Axial length 23.43 mm. Age 71. Optic disc at the center of the field. Corneal thickness 560 µm
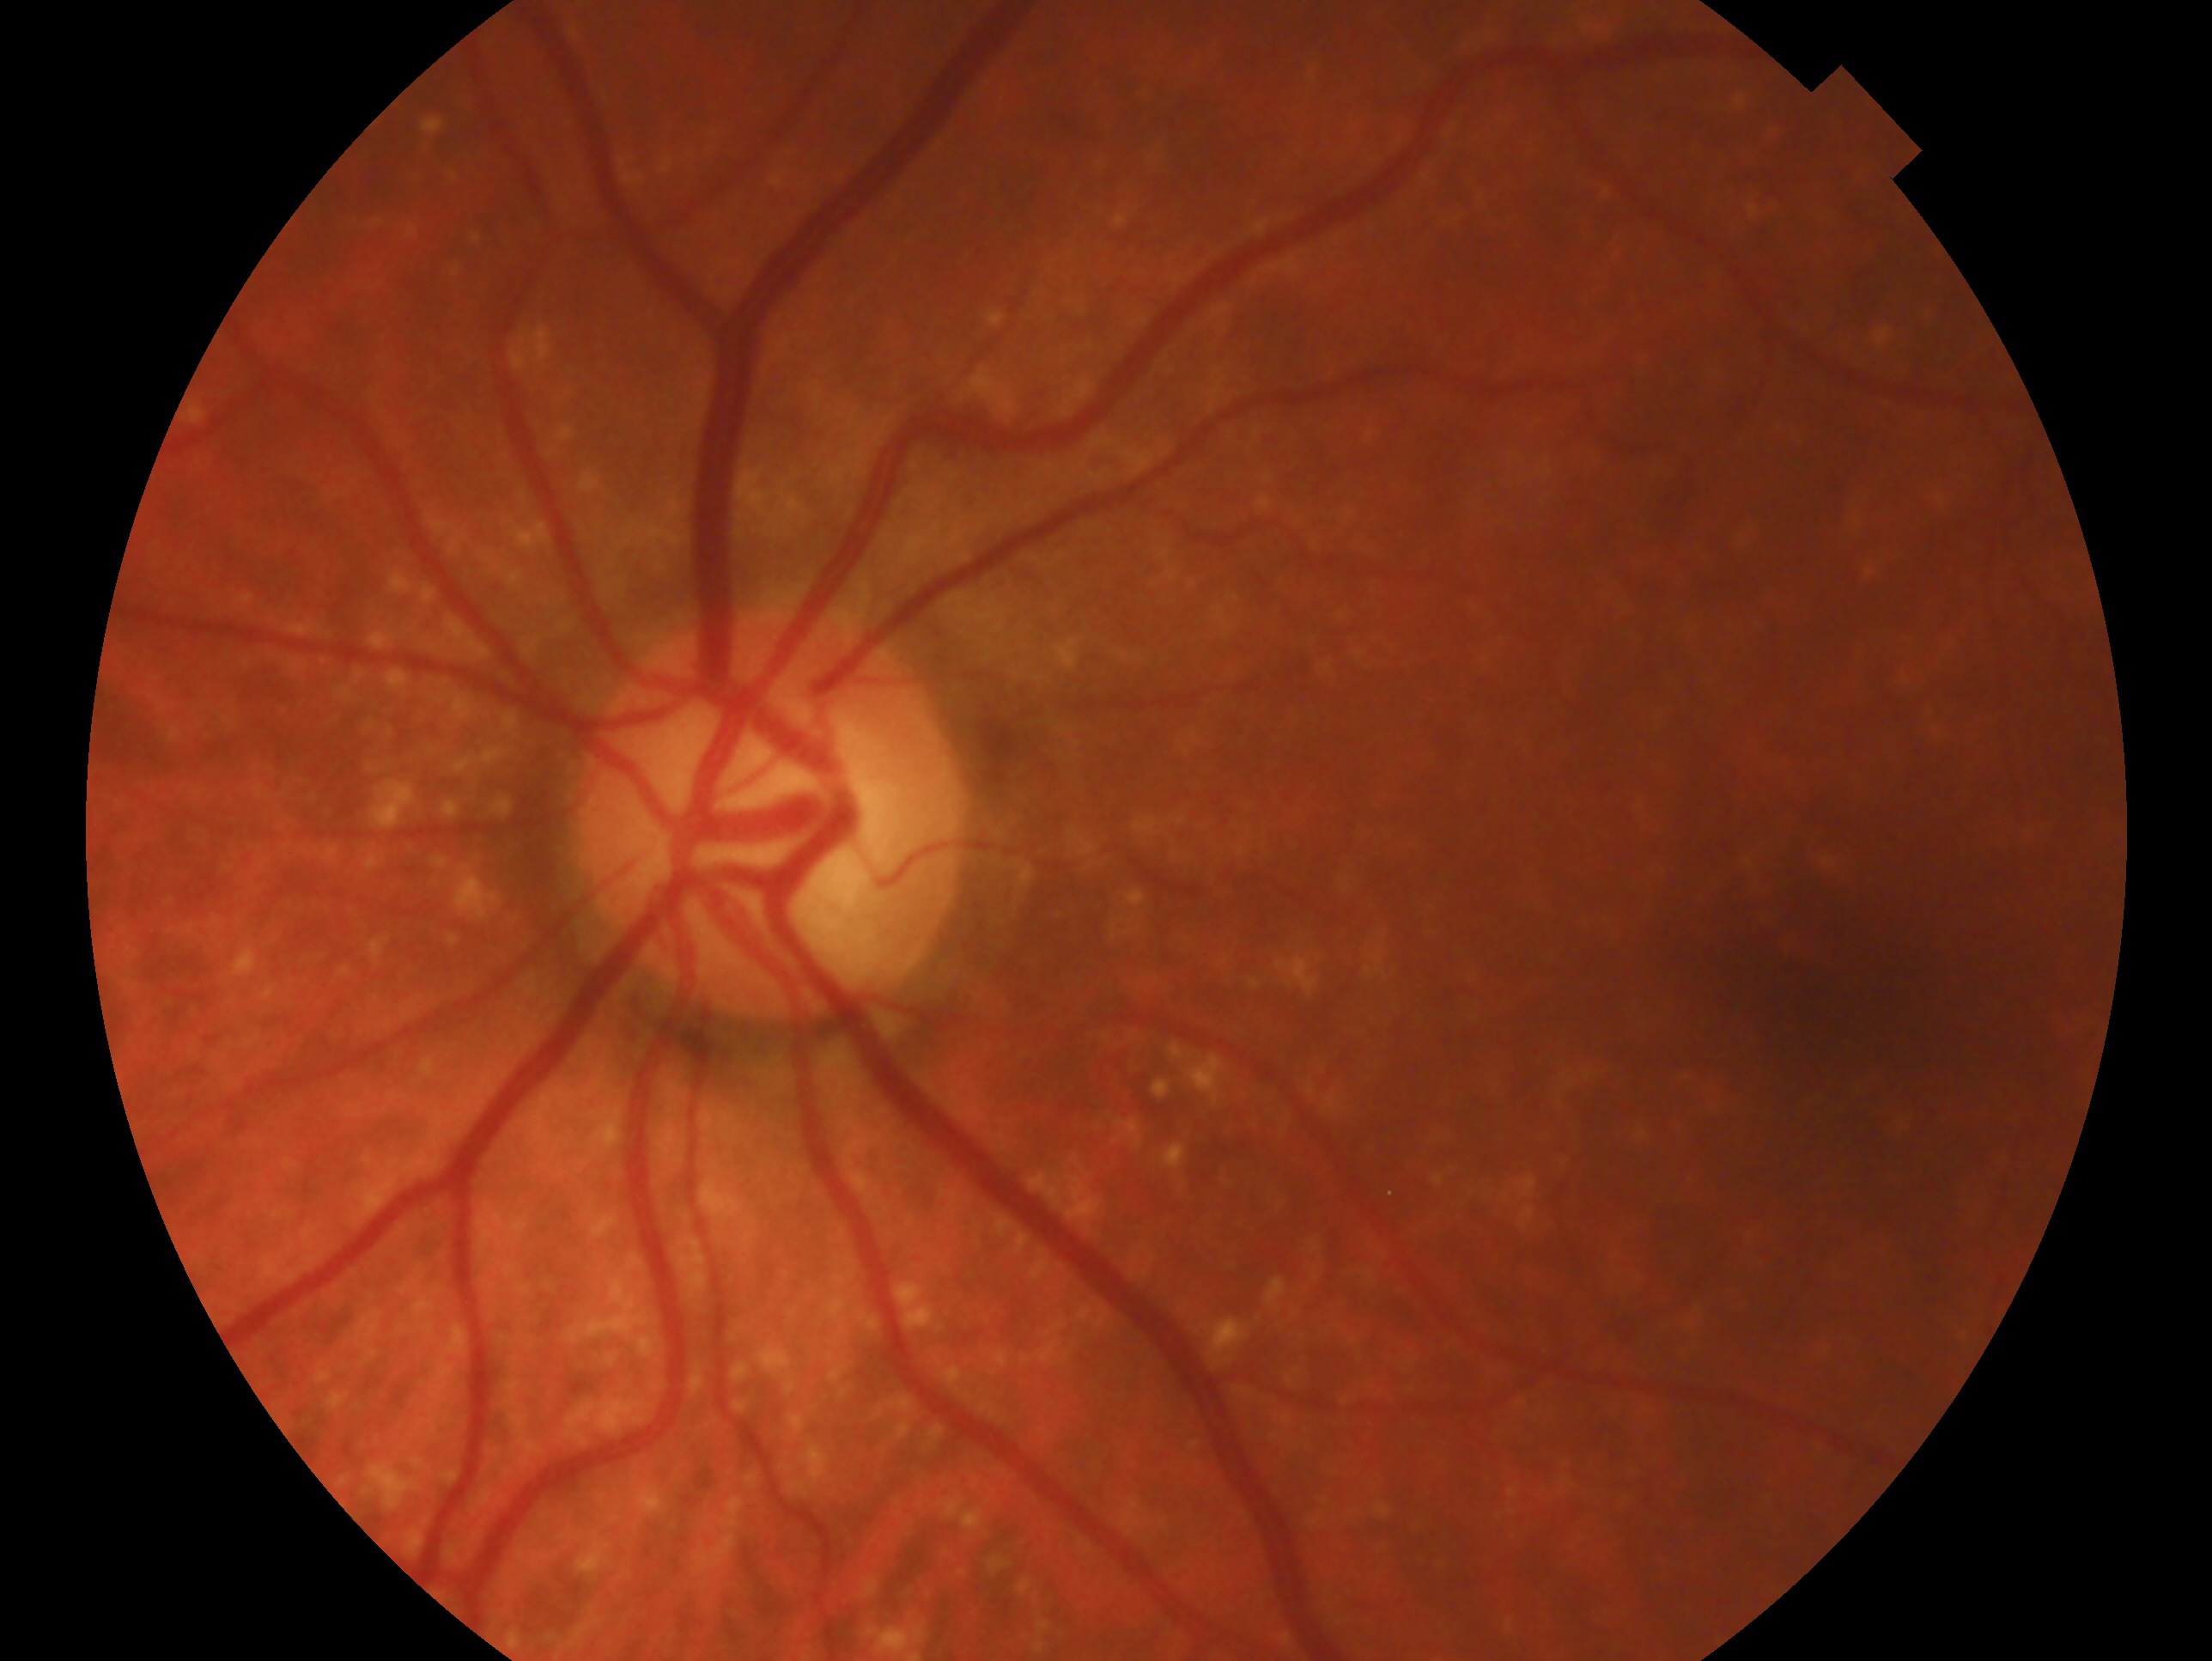 laterality=oculus sinister | glaucoma status=glaucomatous.